45° field of view. Without pupil dilation:
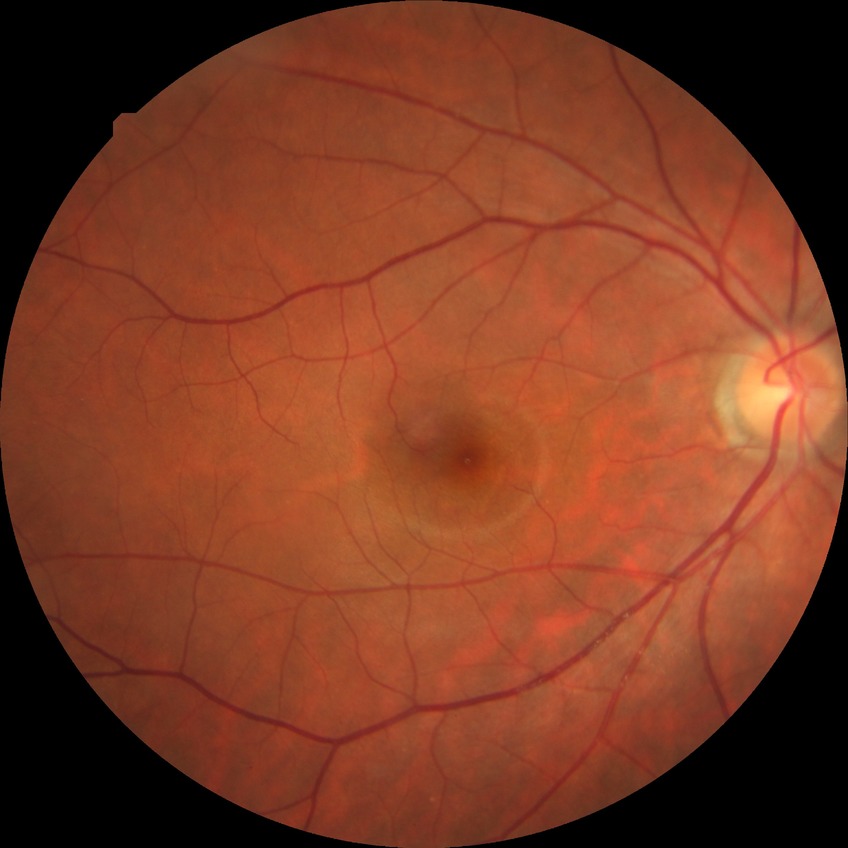
Retinopathy stage is no diabetic retinopathy.